Retinal fundus photograph, FOV: 45 degrees, 2352 by 1568 pixels — 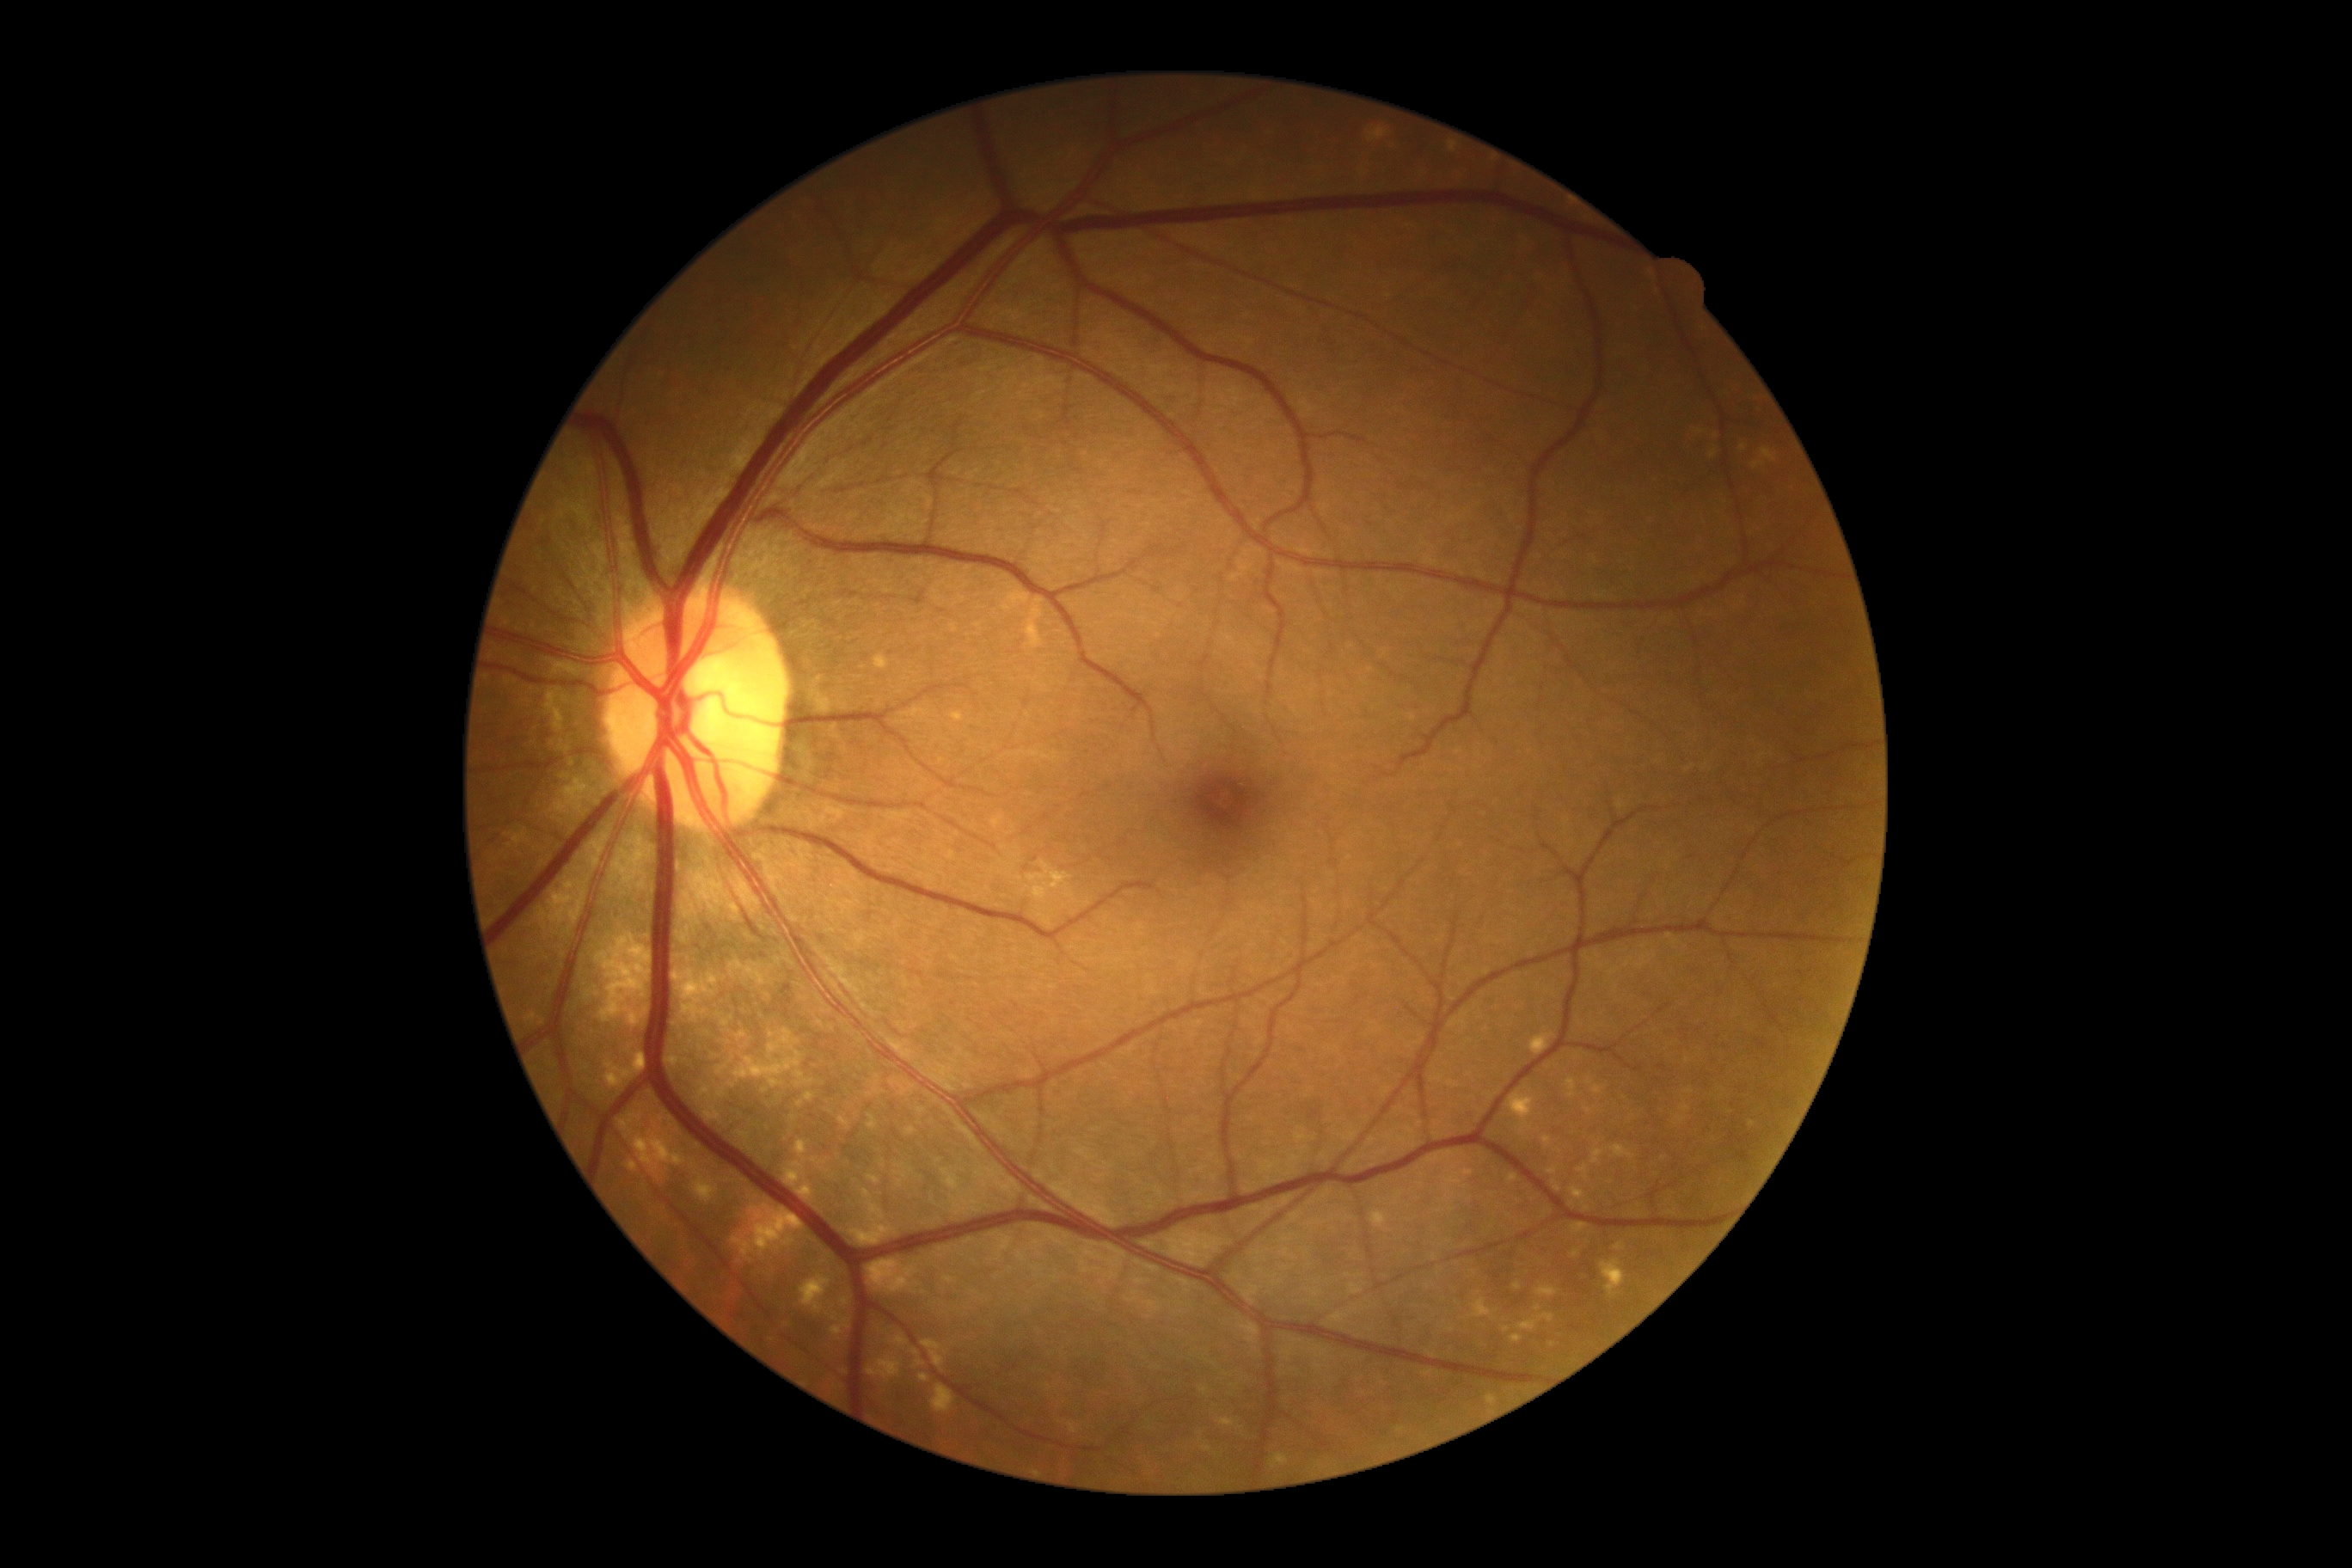   dr_grade: 0